Wide-field fundus image from infant ROP screening:
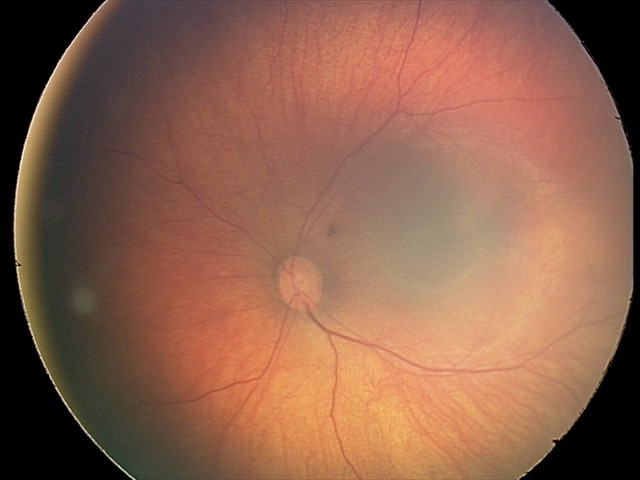

Q: What is the diagnosis from this examination?
A: retinal hemorrhages